640 by 480 pixels; wide-field contact fundus photograph of an infant.
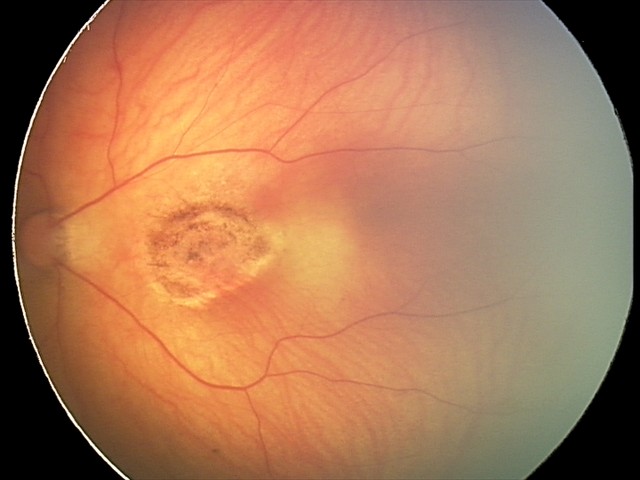

Assessment: toxoplasmosis chorioretinitis.